2212 by 1659 pixels; retinal fundus photograph; 45° FOV:
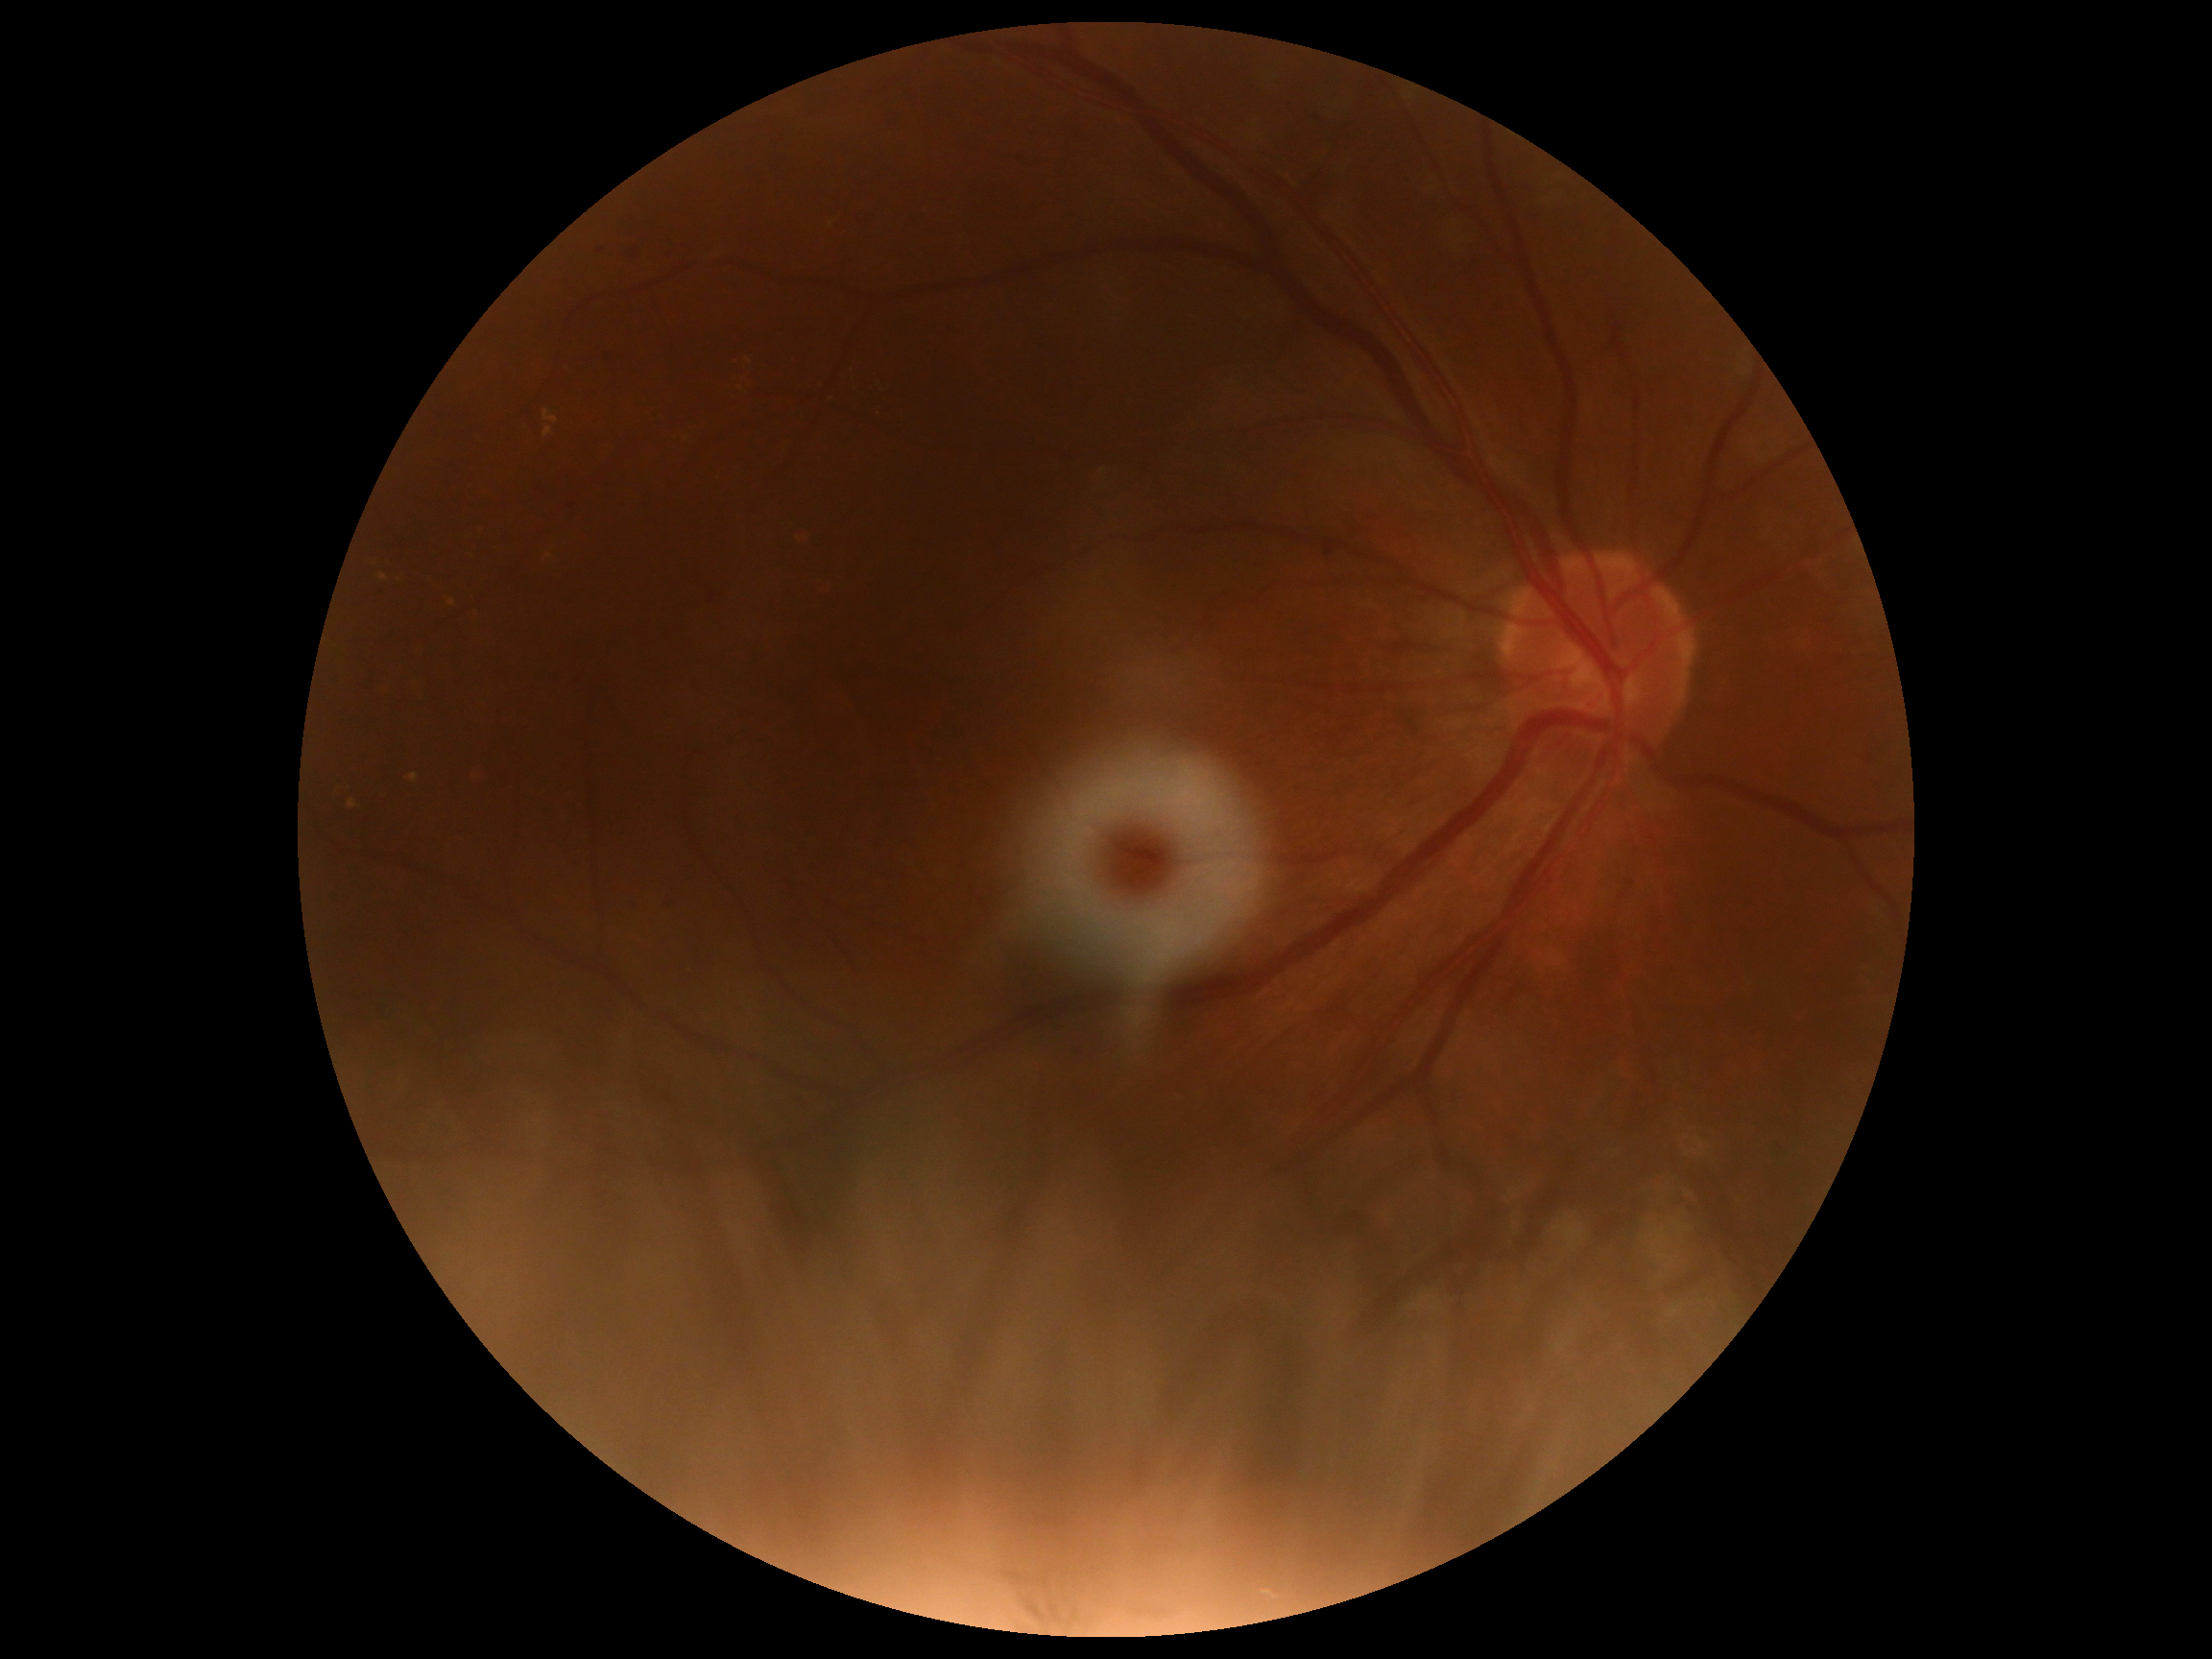

DR class: non-proliferative diabetic retinopathy.
DR is moderate non-proliferative diabetic retinopathy (grade 2).